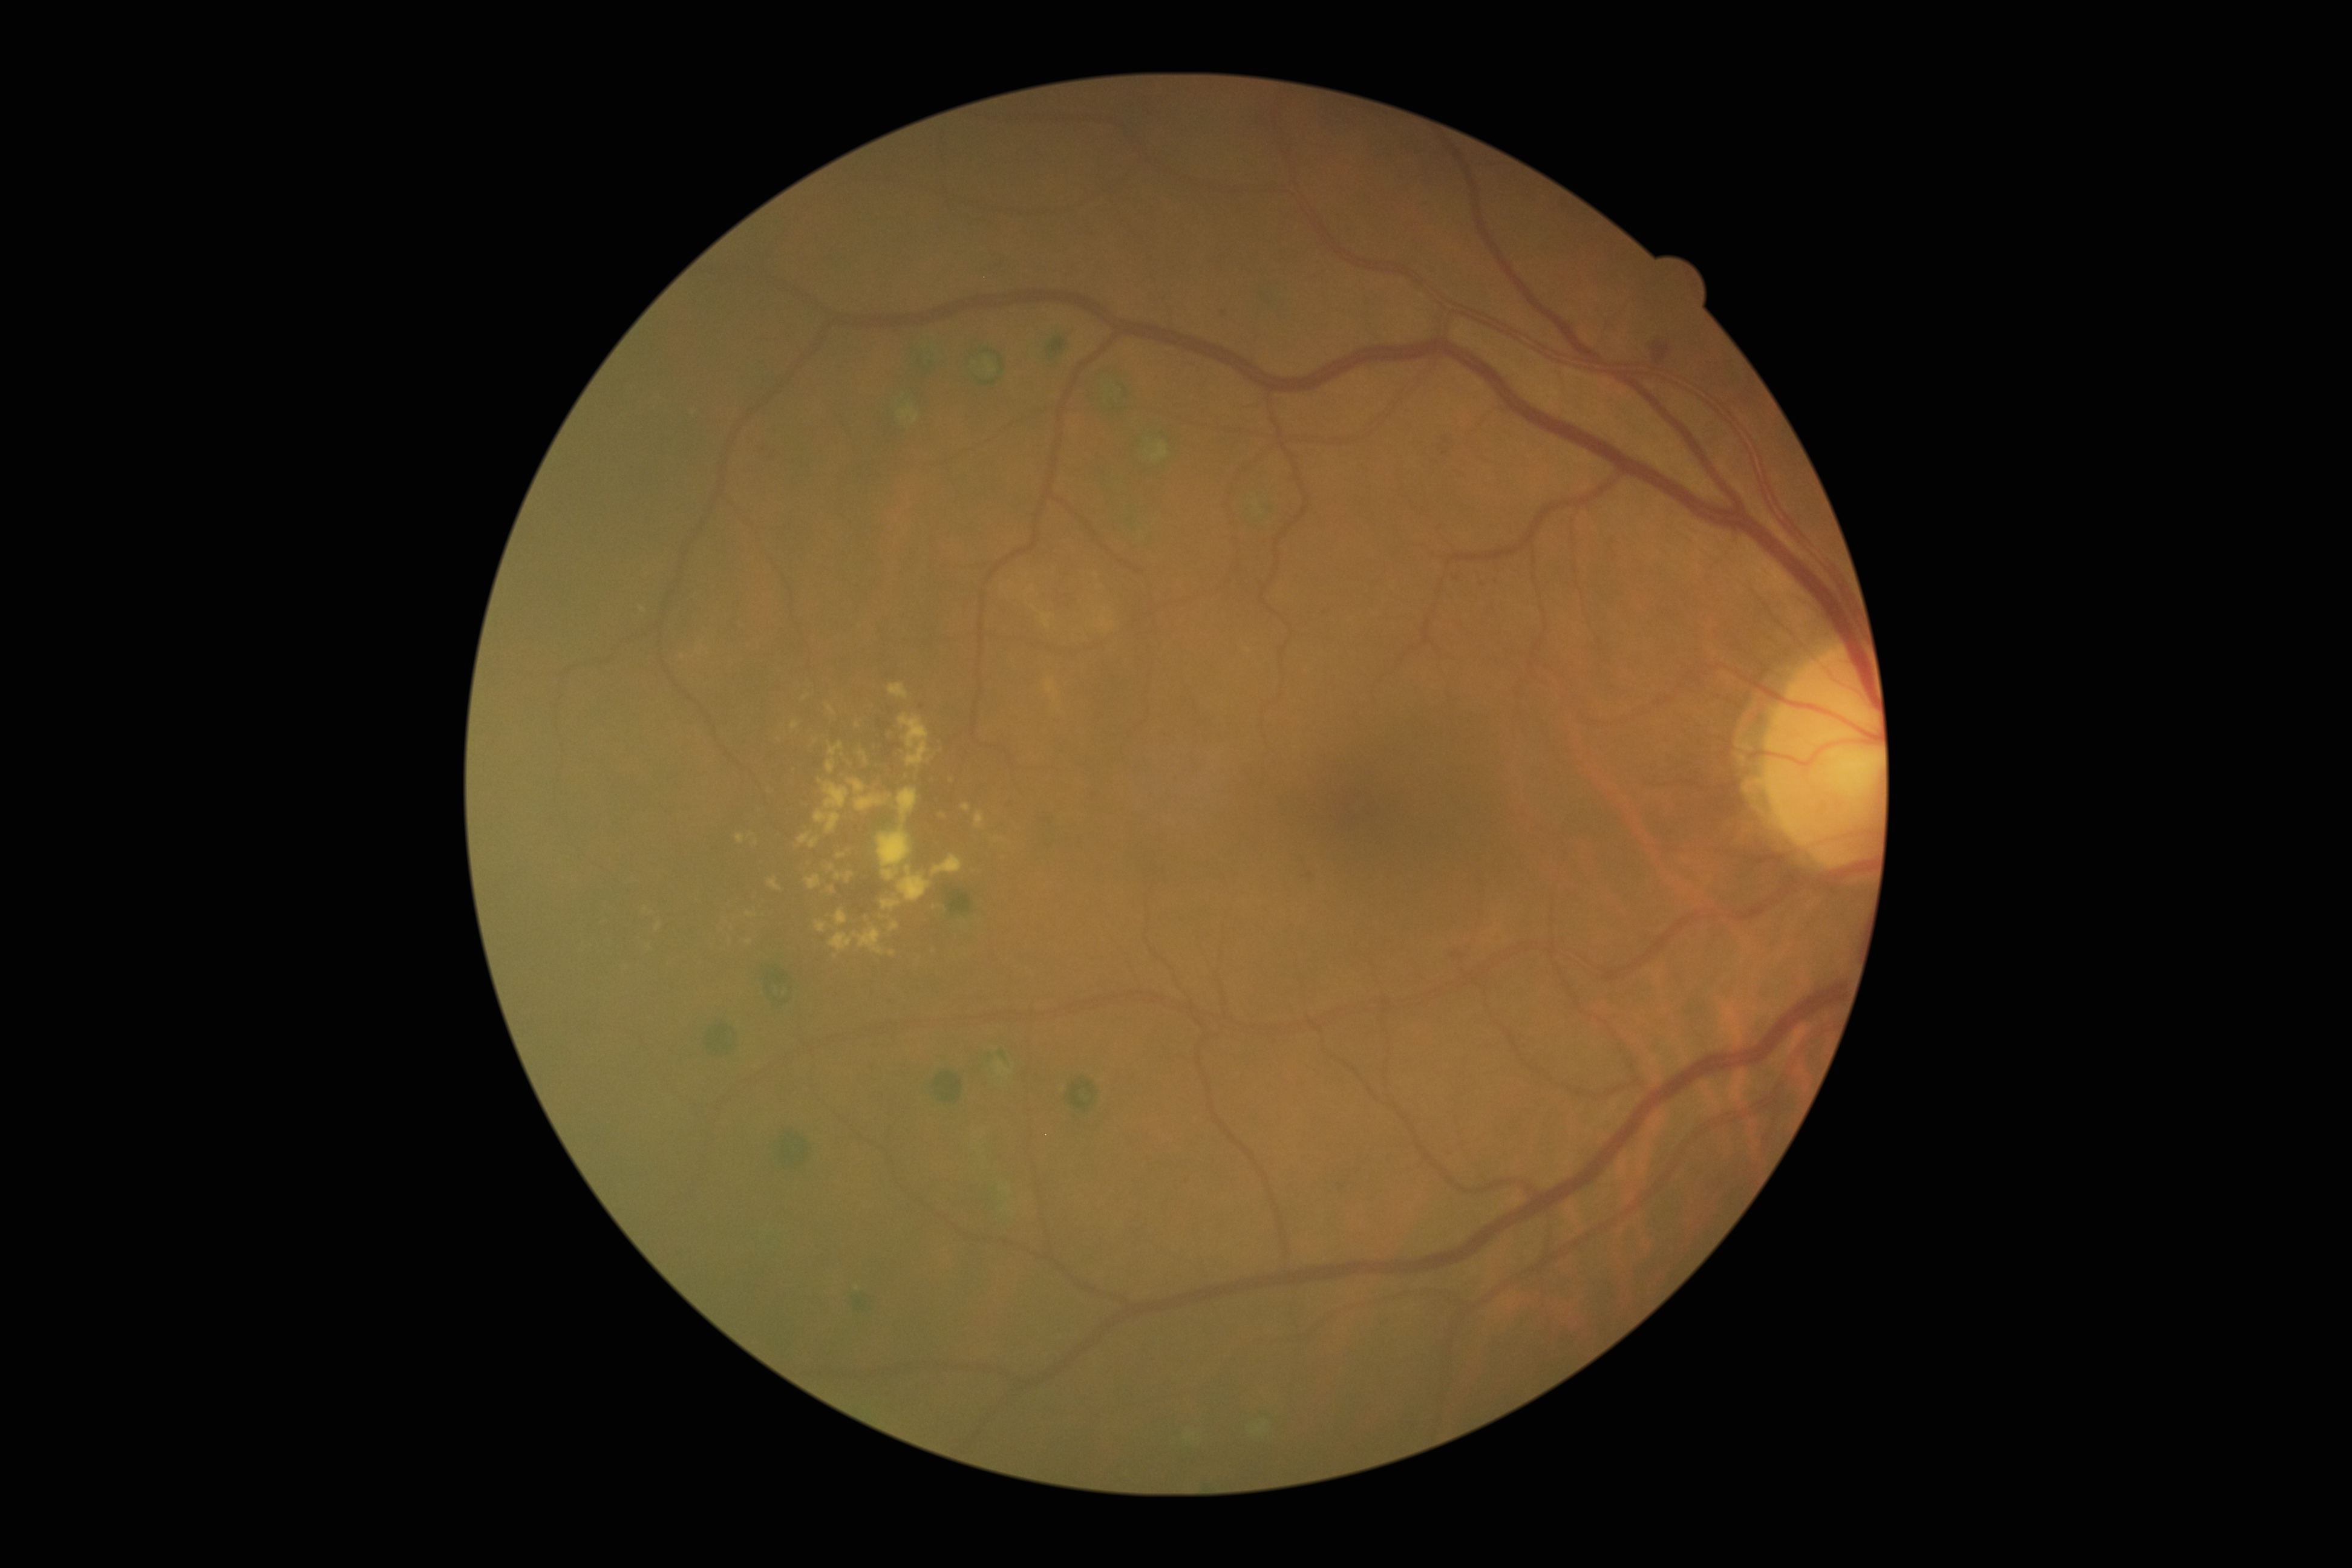 DR severity: moderate non-proliferative diabetic retinopathy (grade 2). EXs are present, including at [x1=835, y1=909, x2=848, y2=926]; [x1=828, y1=864, x2=835, y2=872]; [x1=889, y1=683, x2=909, y2=699]; [x1=900, y1=714, x2=931, y2=766]; [x1=805, y1=875, x2=821, y2=890]; [x1=768, y1=879, x2=782, y2=891]; [x1=792, y1=720, x2=799, y2=729]; [x1=897, y1=788, x2=919, y2=825]; [x1=961, y1=803, x2=971, y2=811]; [x1=860, y1=751, x2=868, y2=764]; [x1=814, y1=810, x2=840, y2=834]. EXs (small, approximate centers) near (806,698); (756,842); (997,840).